NIDEK AFC-230 fundus camera · nonmydriatic fundus photograph.
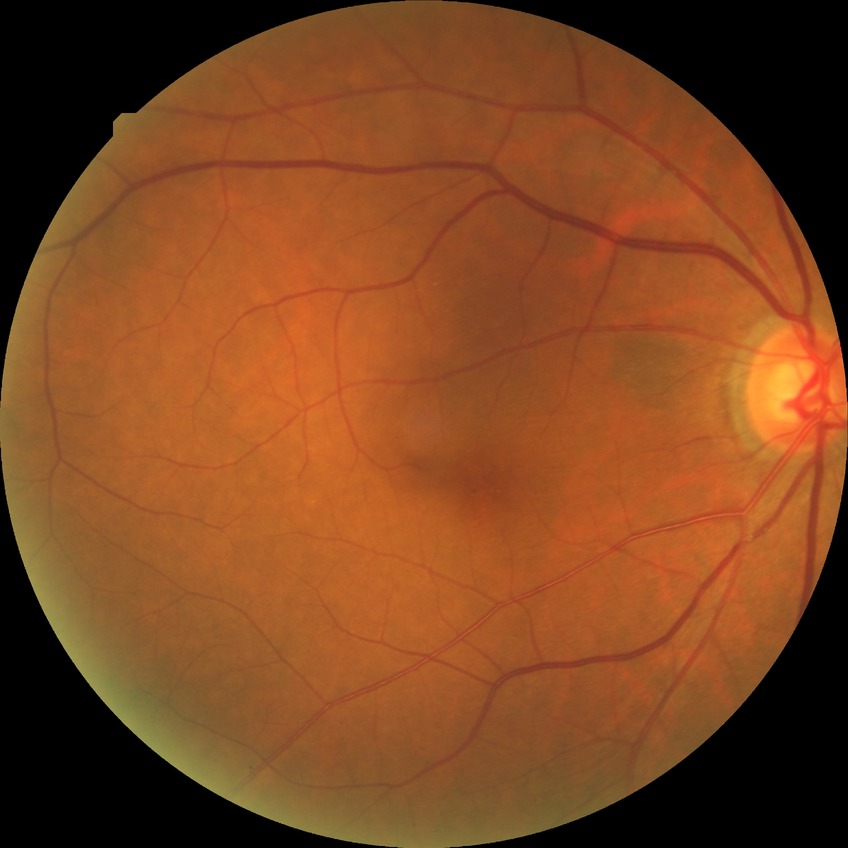
Modified Davis classification is no diabetic retinopathy.